2048x1536px
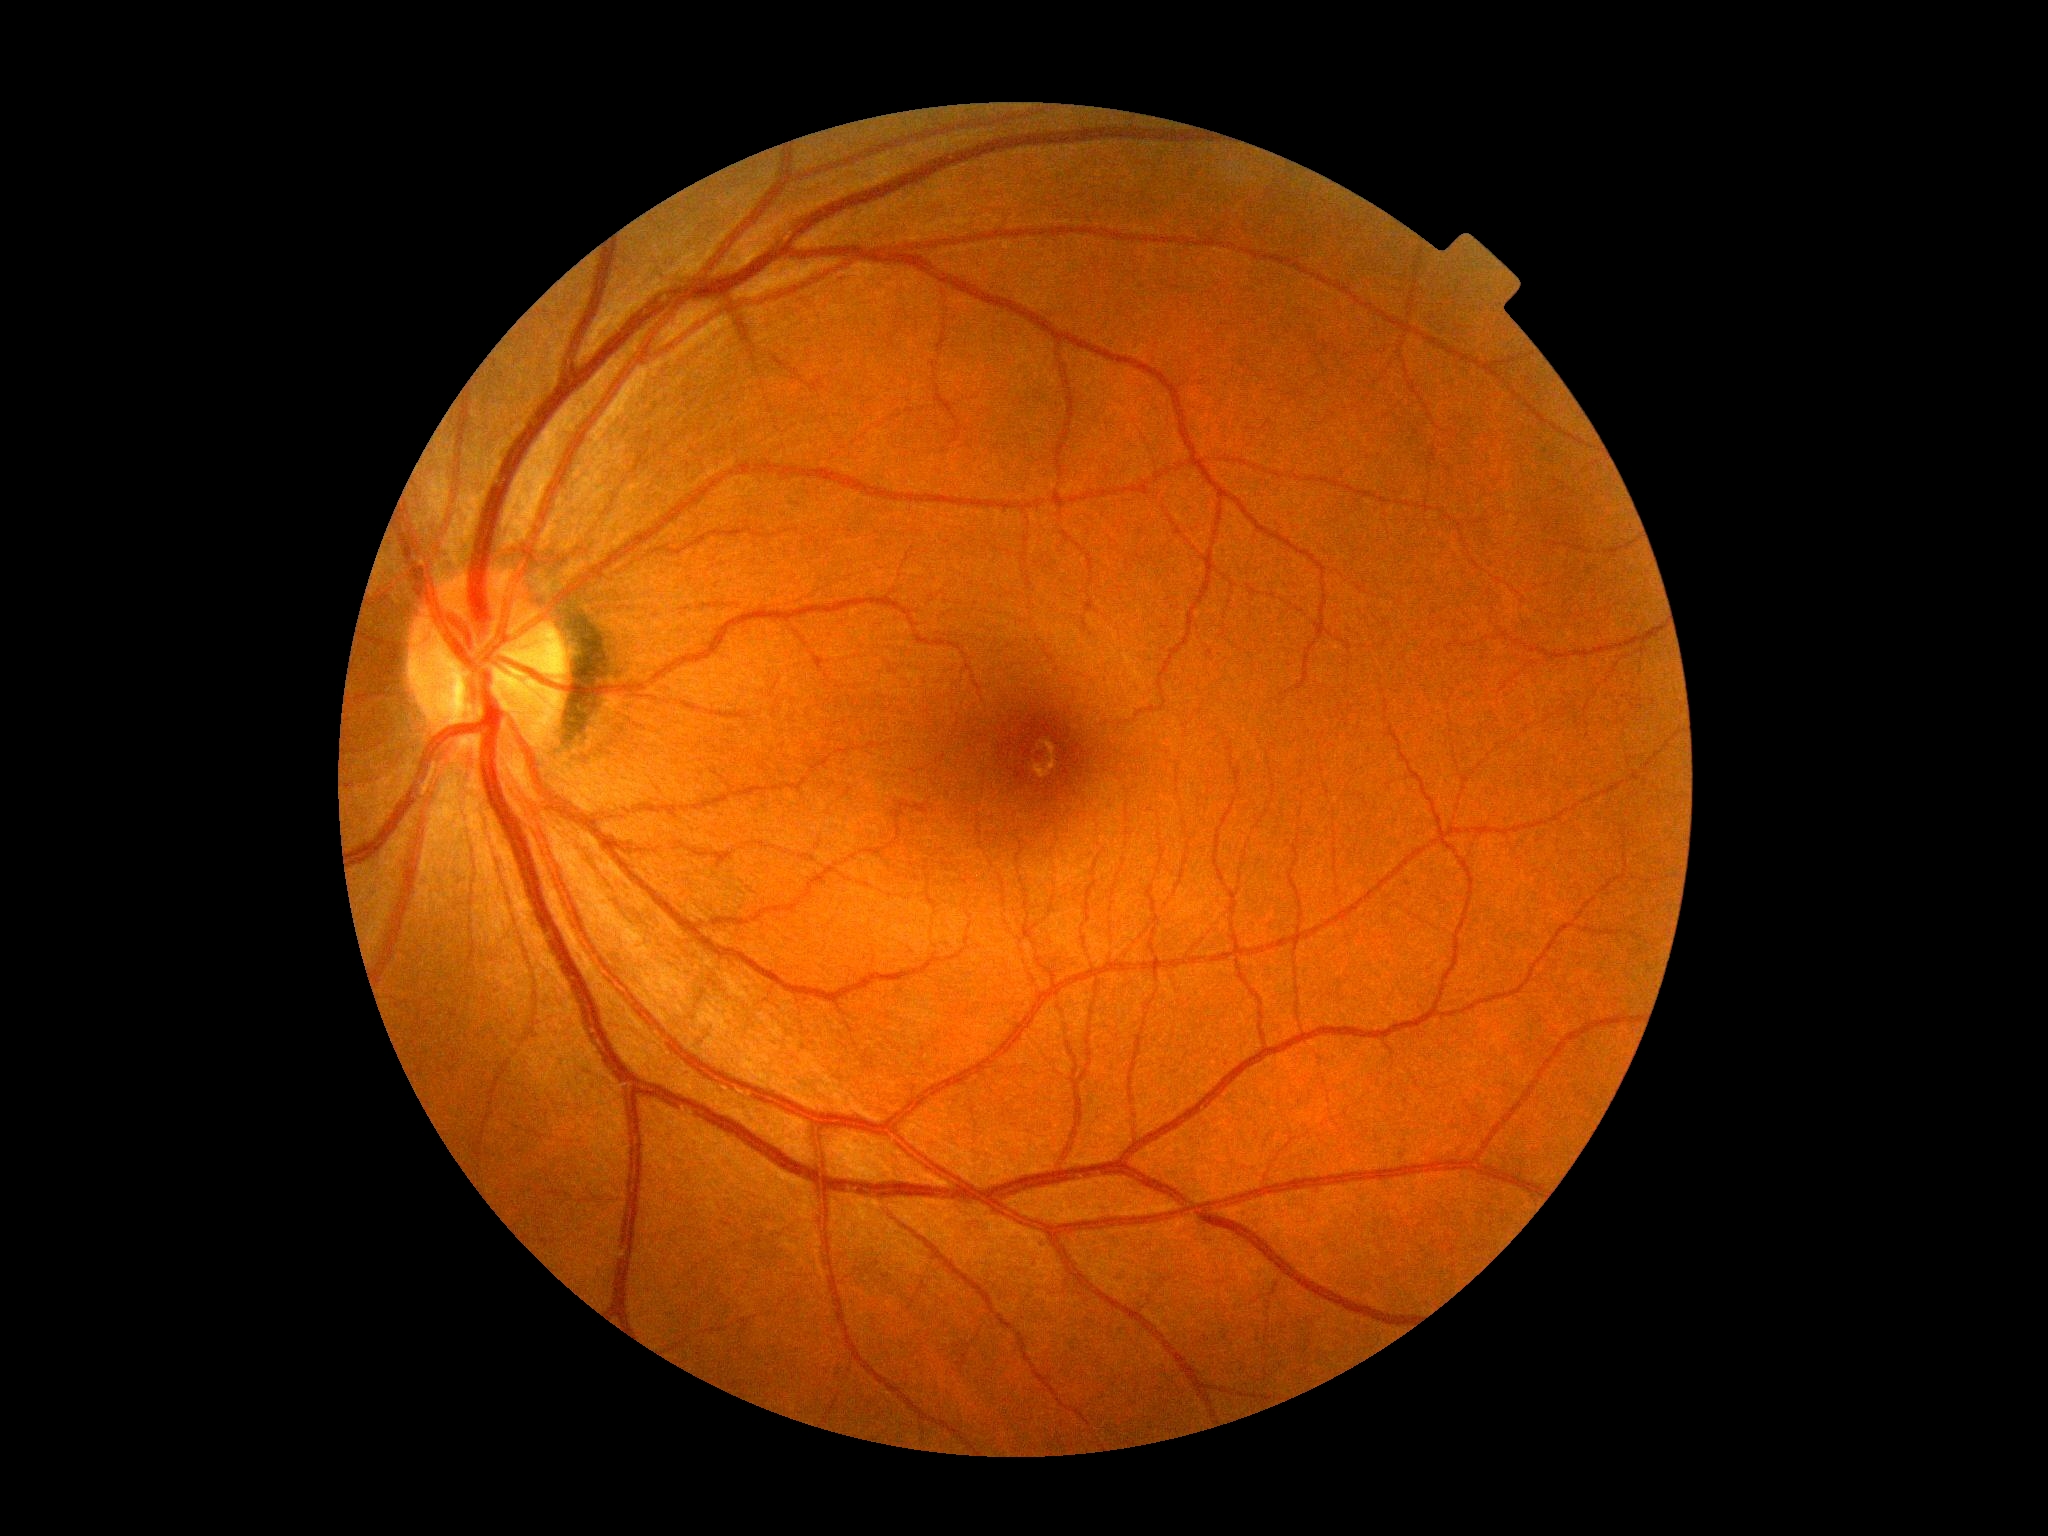 DR grade: 0.